Wide-field contact fundus photograph of an infant. 100° field of view (Phoenix ICON)
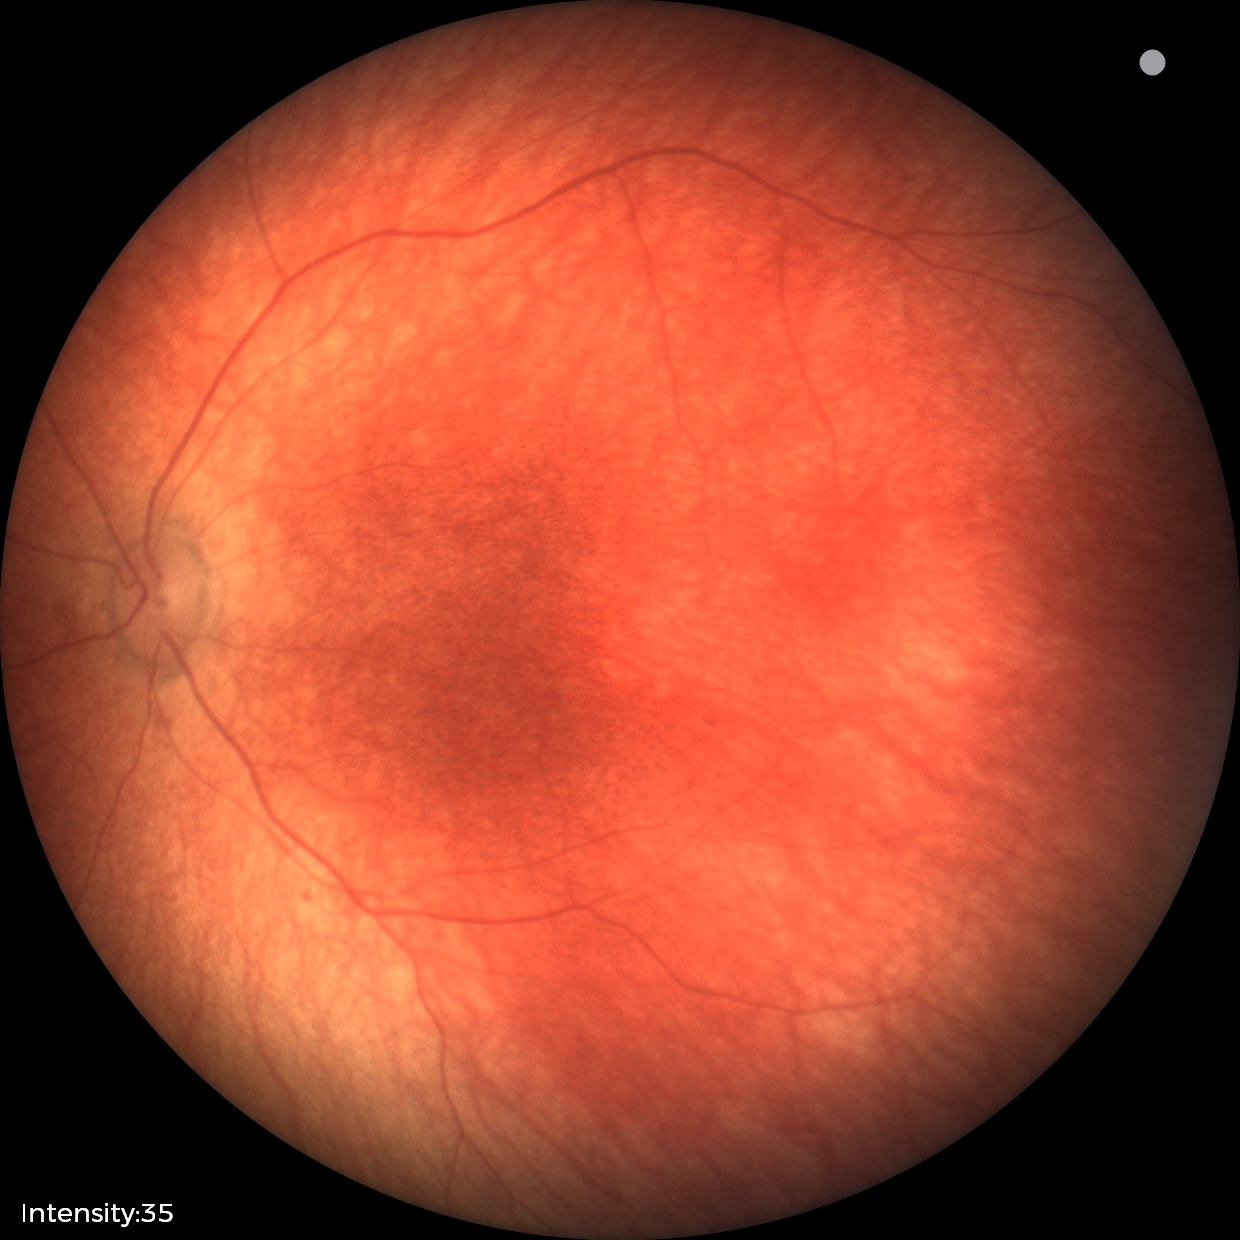

Screening: normal fundus examination.